Image size 2048x1536. Acquired with a Forus 3Nethra fundus camera.
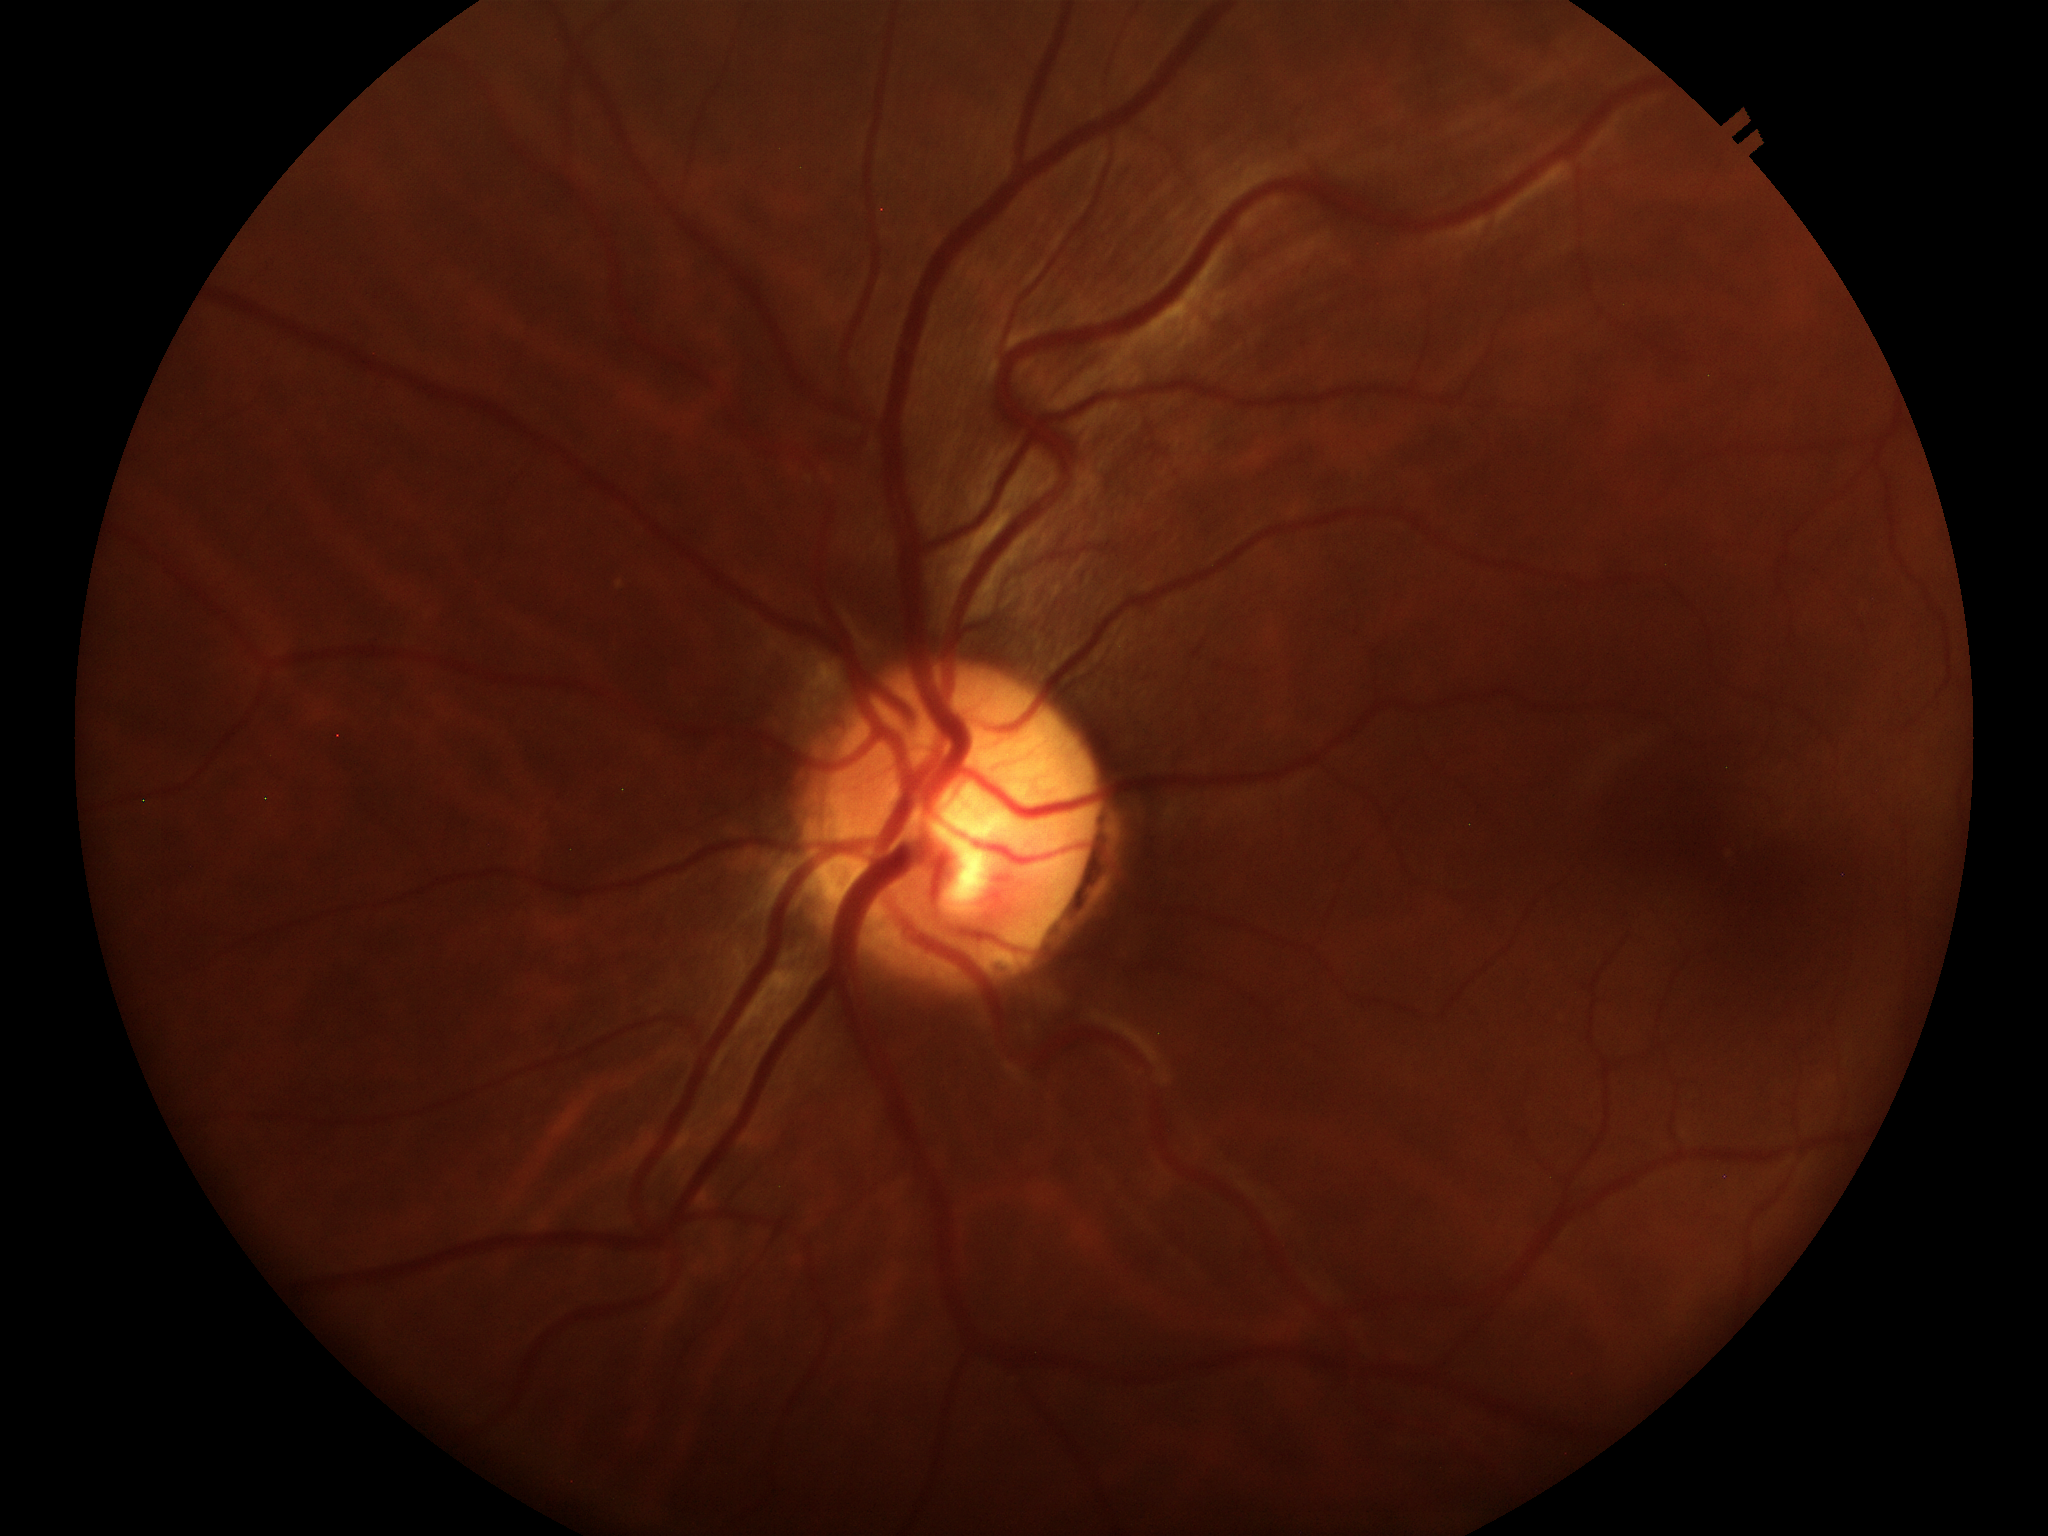 Not suspicious for glaucoma (2 of 5 graders flagged glaucoma suspect). Vertical C/D ratio (VCDR) is 0.58. Horizontal cup-disc ratio (HCDR) is 0.45.